Camera: NIDEK AFC-230 · DR severity per modified Davis staging · 45° field of view
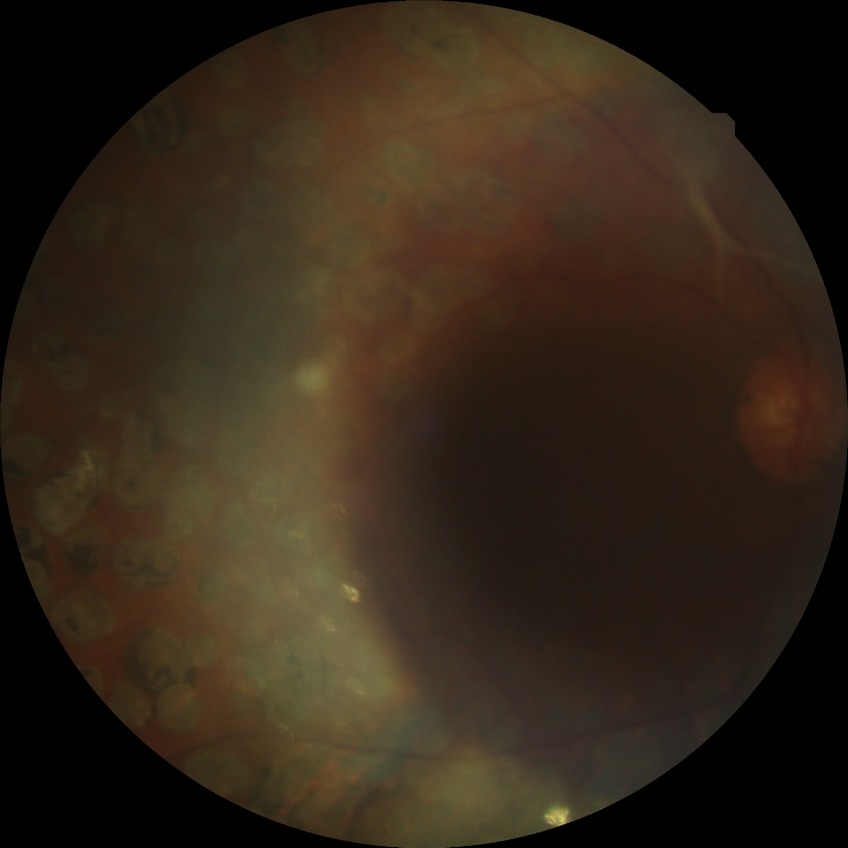

Diabetic retinopathy (DR) is PDR (proliferative diabetic retinopathy).